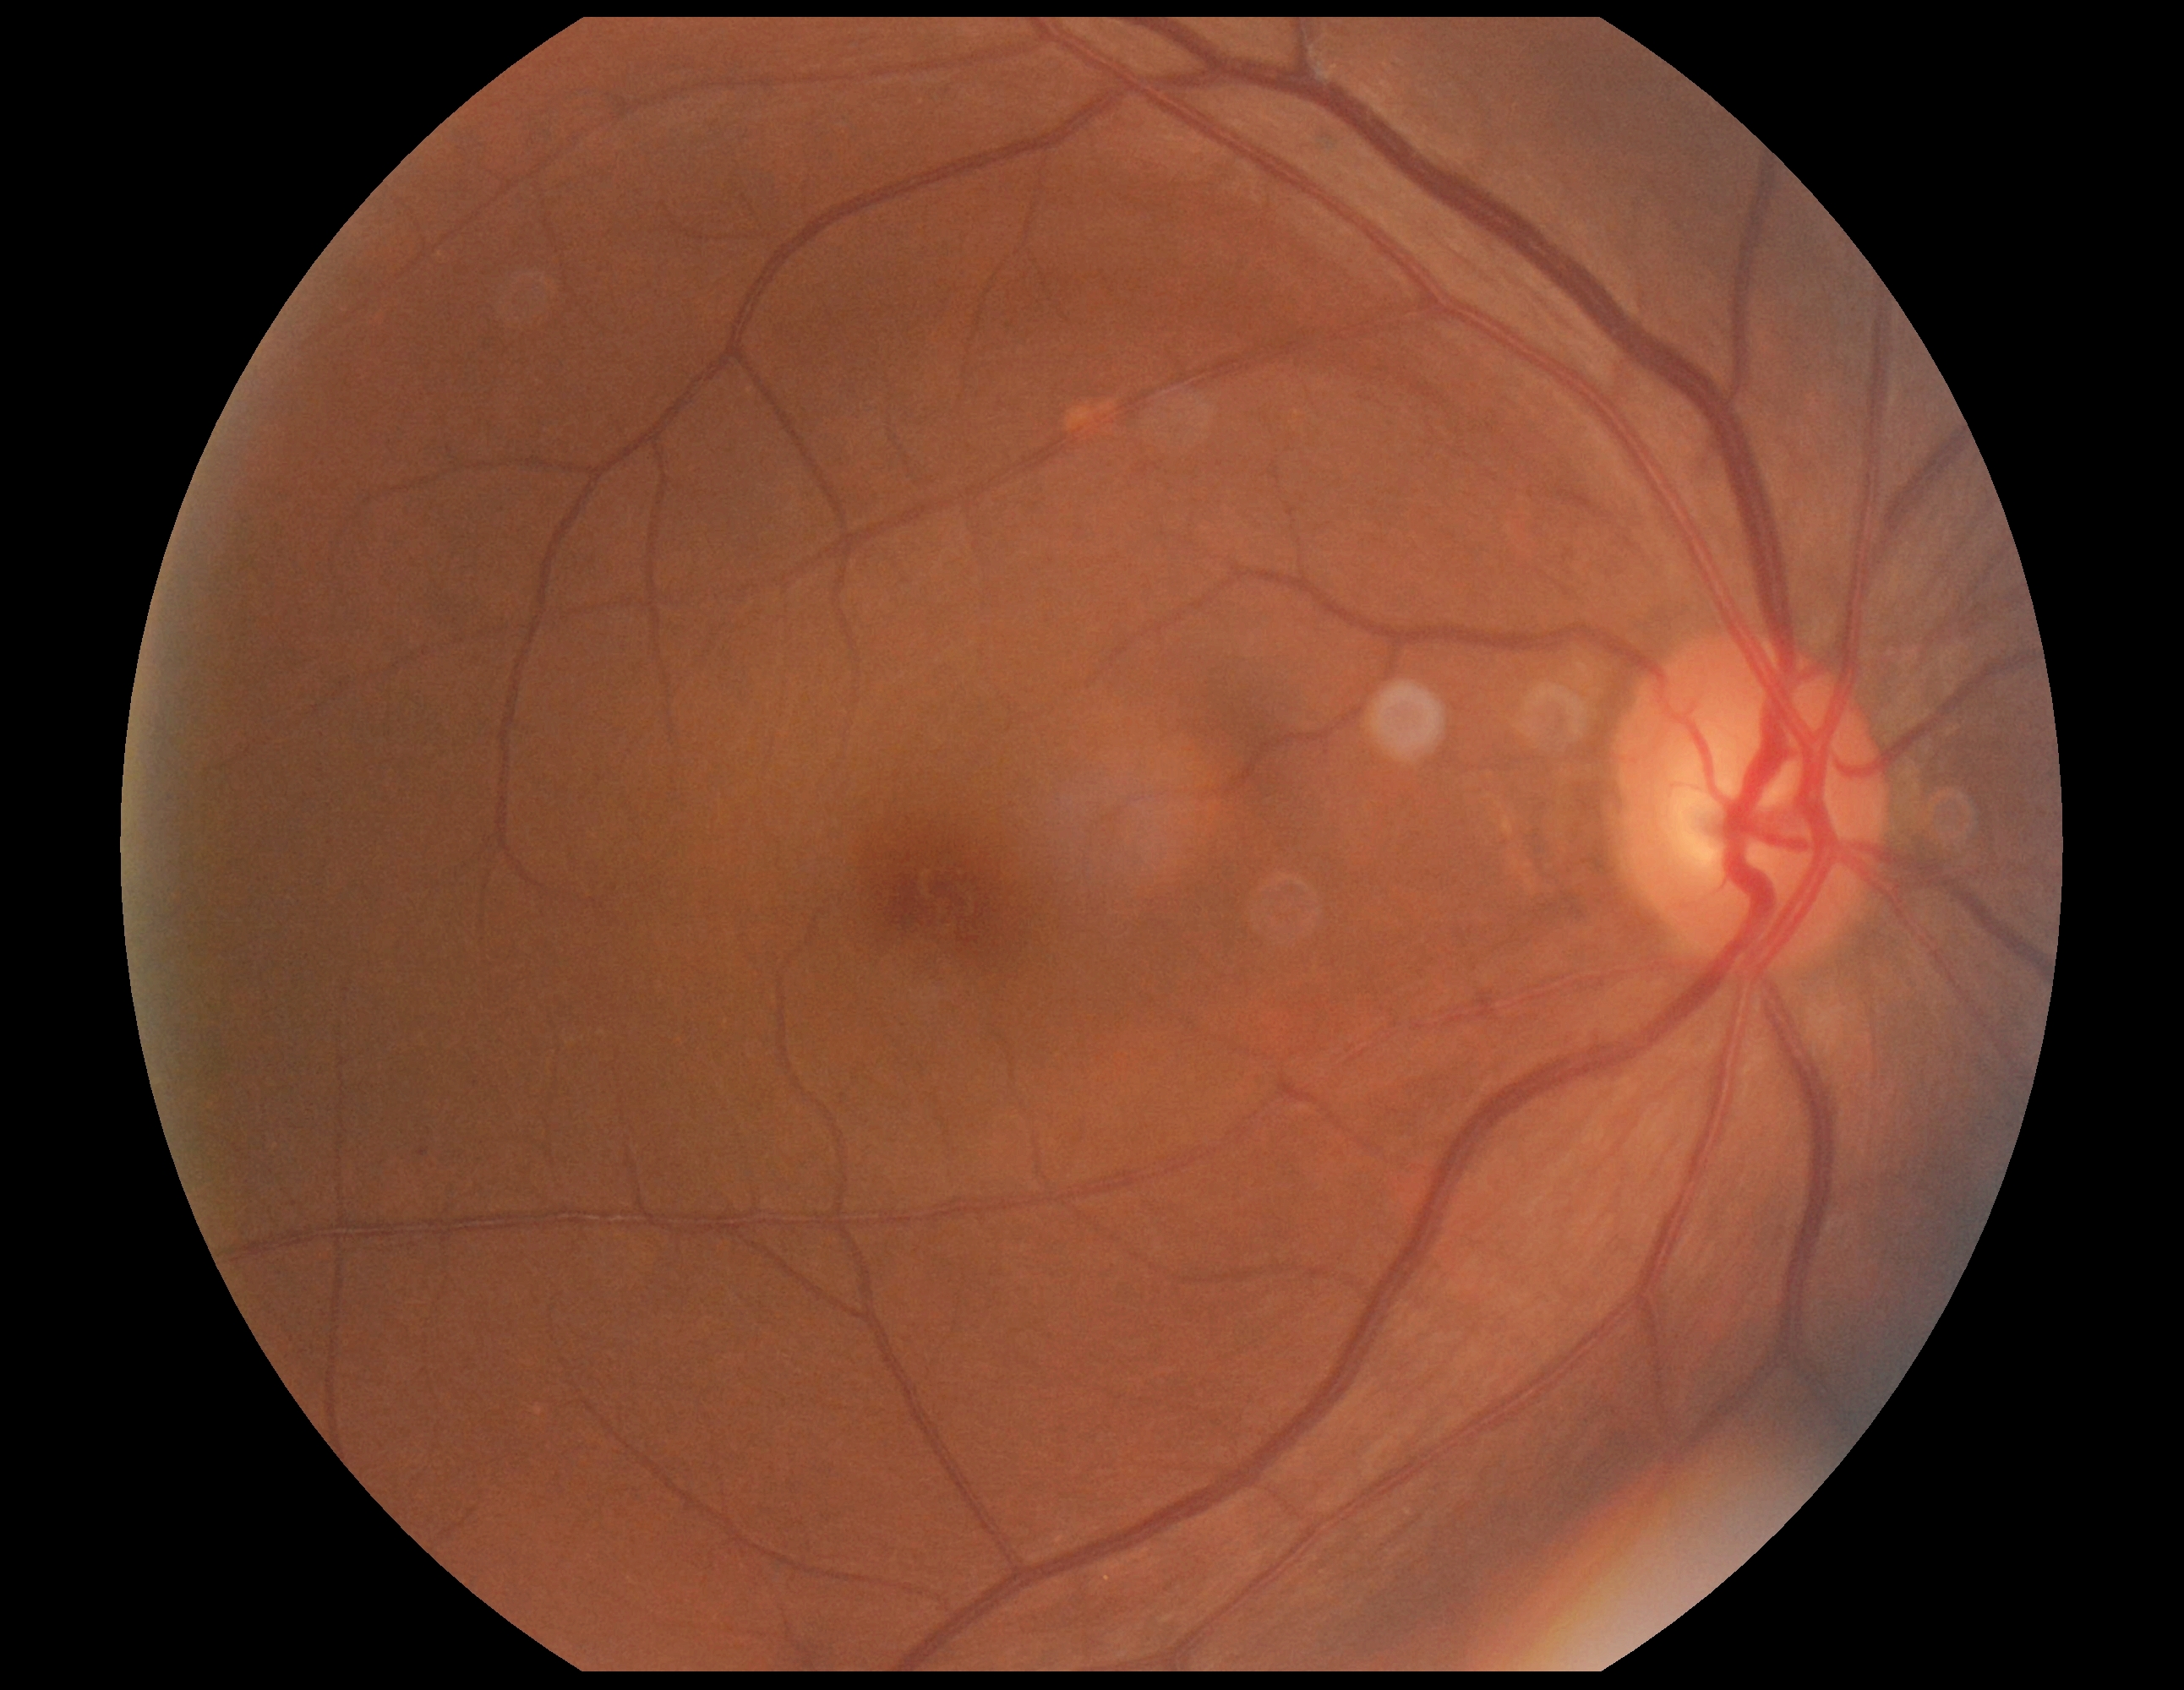

No apparent diabetic retinopathy.
DR: 0/4.